2212x1659 · CFP · 45-degree field of view:
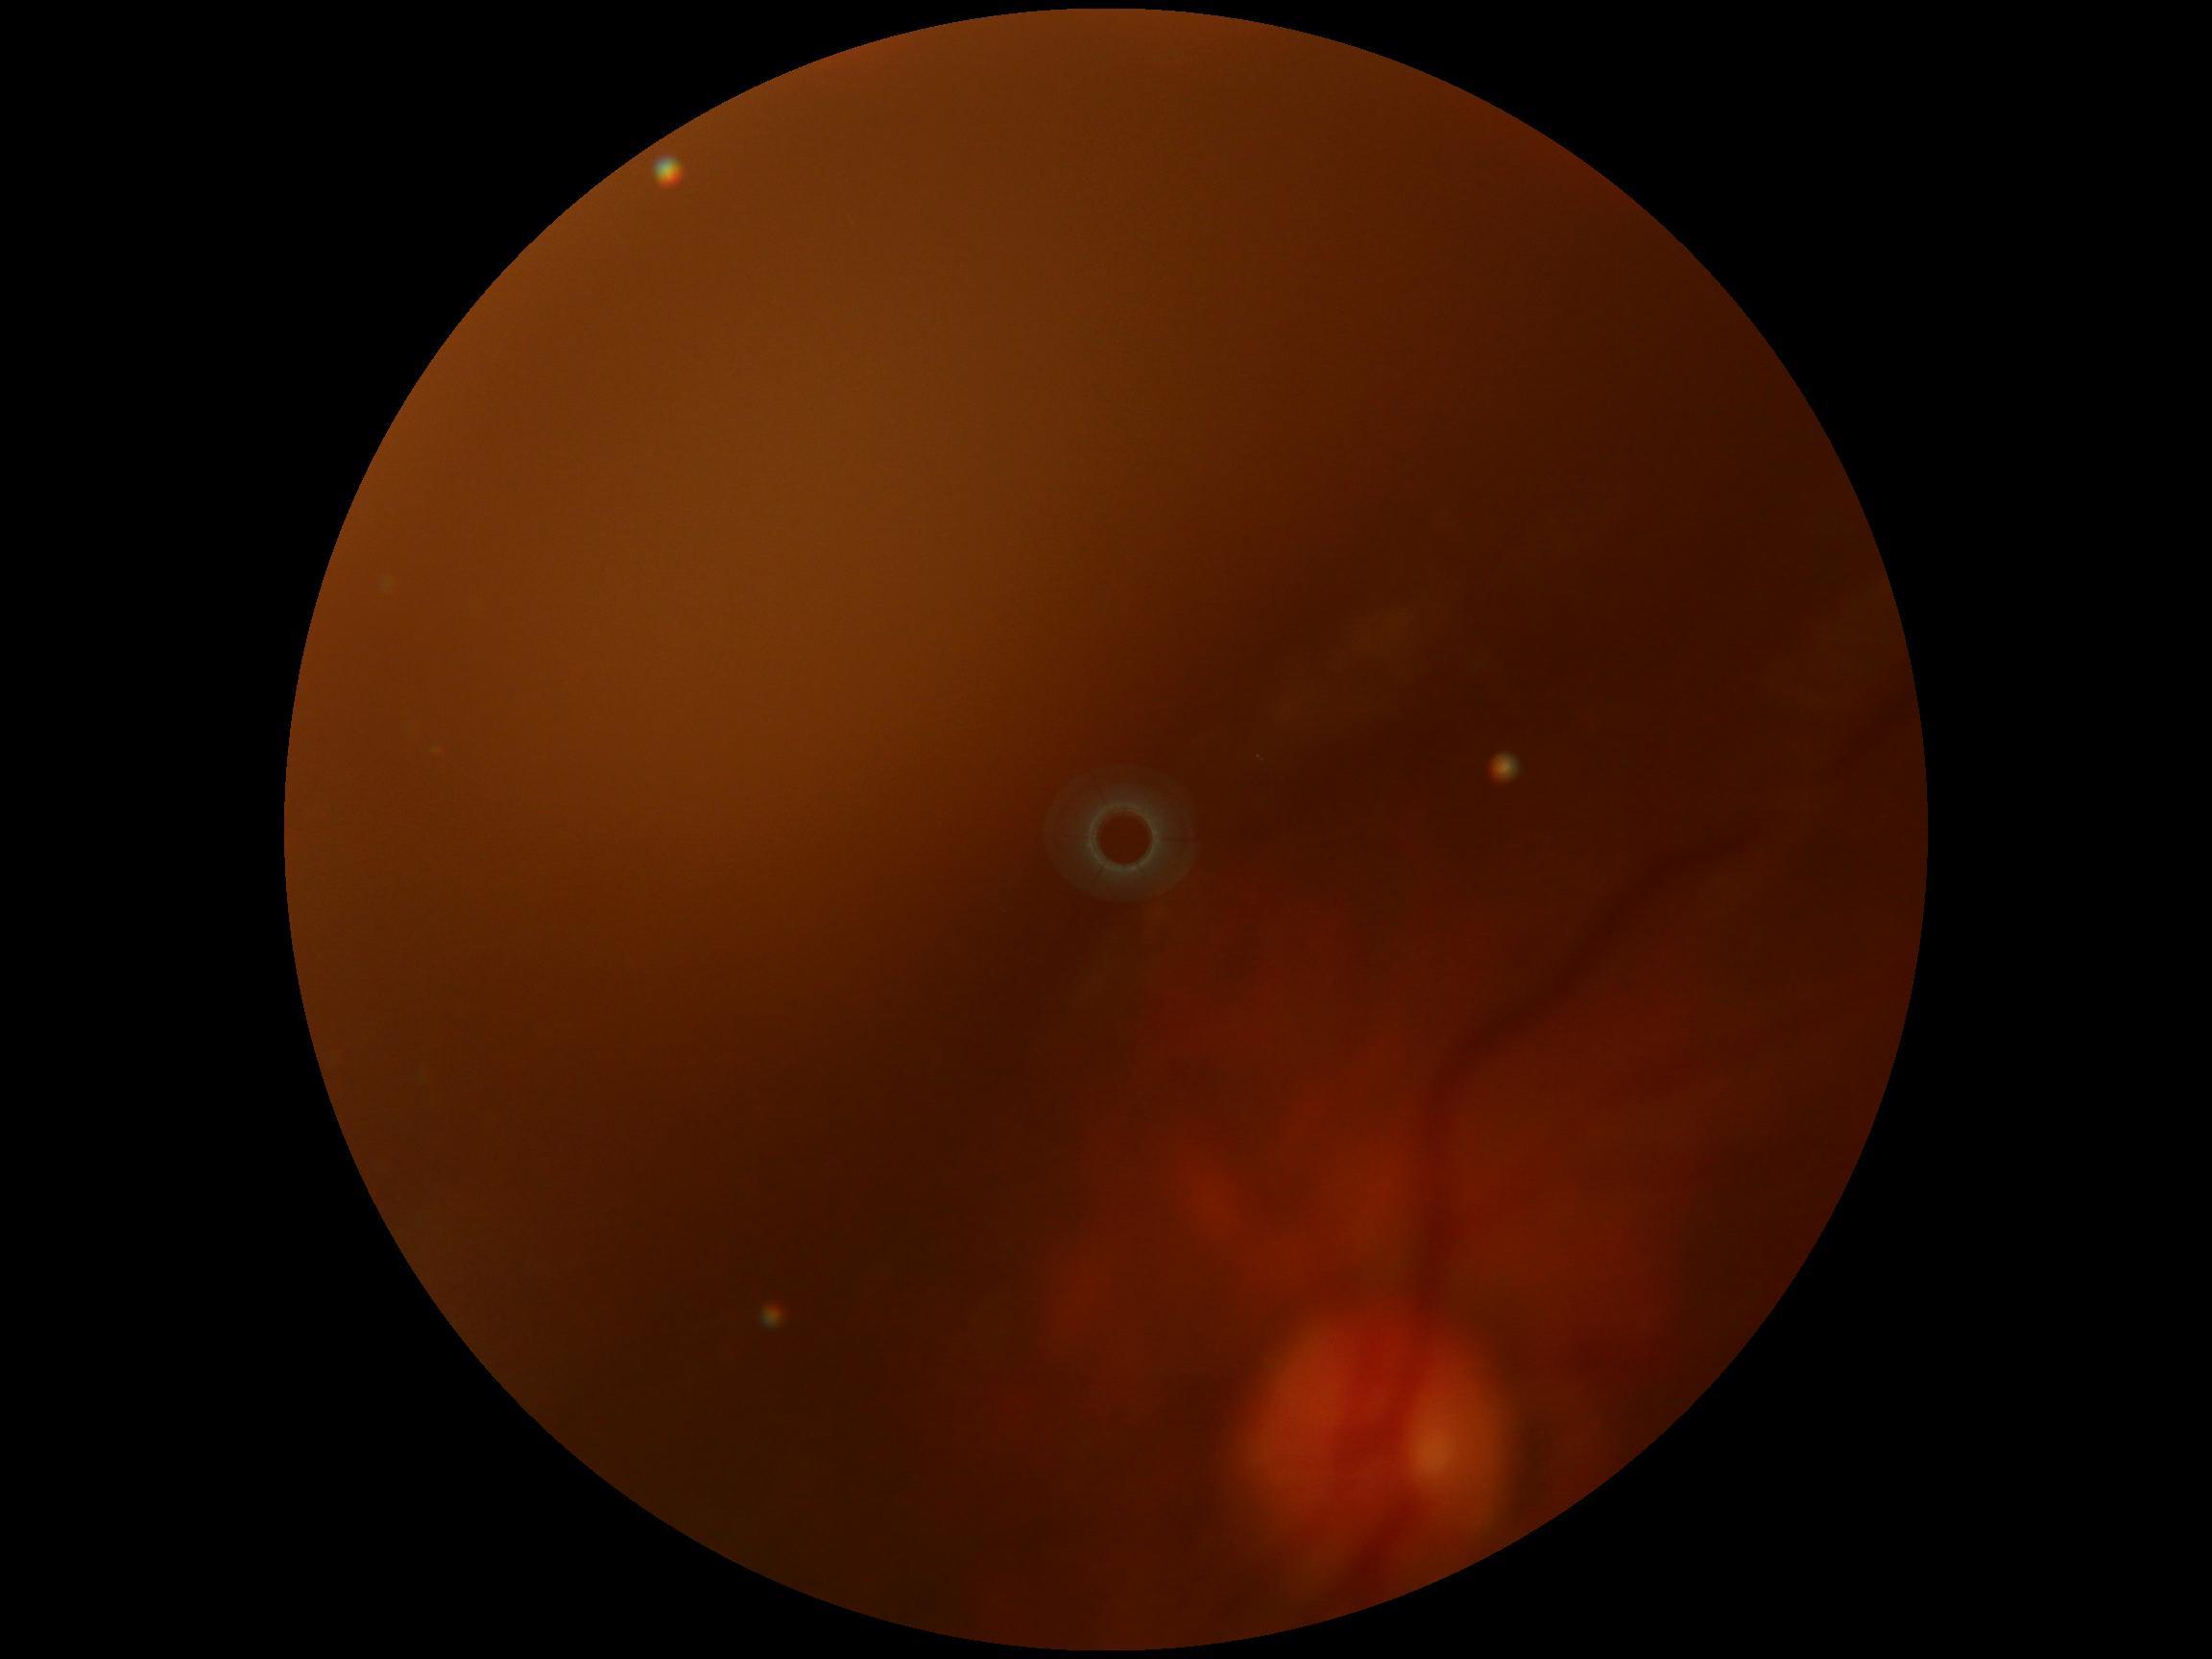

Quality too poor to assess for DR.
DR is ungradable.